RetCam wide-field infant fundus image. 640x480.
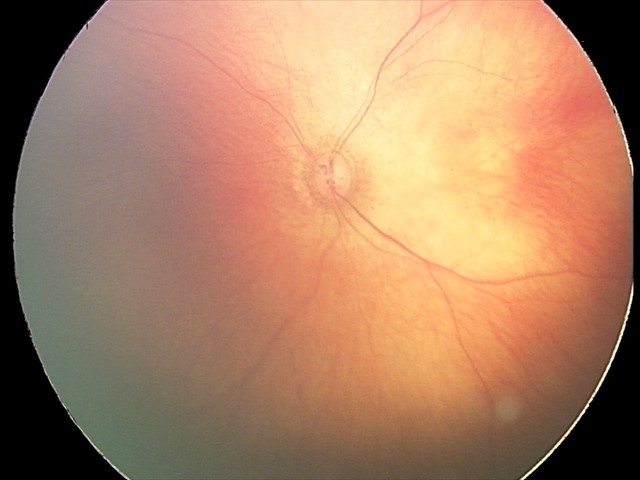

Screening examination consistent with retinal hemorrhages.